640 x 480 pixels · wide-field fundus photograph from neonatal ROP screening · acquired on the Clarity RetCam 3.
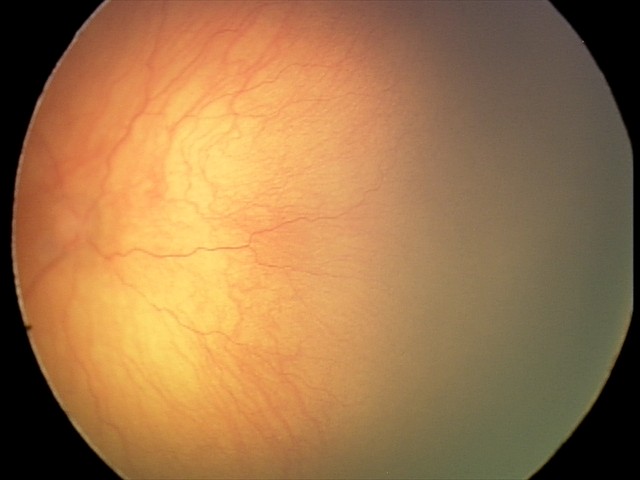

From an examination with diagnosis of aggressive retinopathy of prematurity — rapidly progressive severe ROP with prominent plus disease, often without classic stage progression.